CFP, image size 1534x1534 — 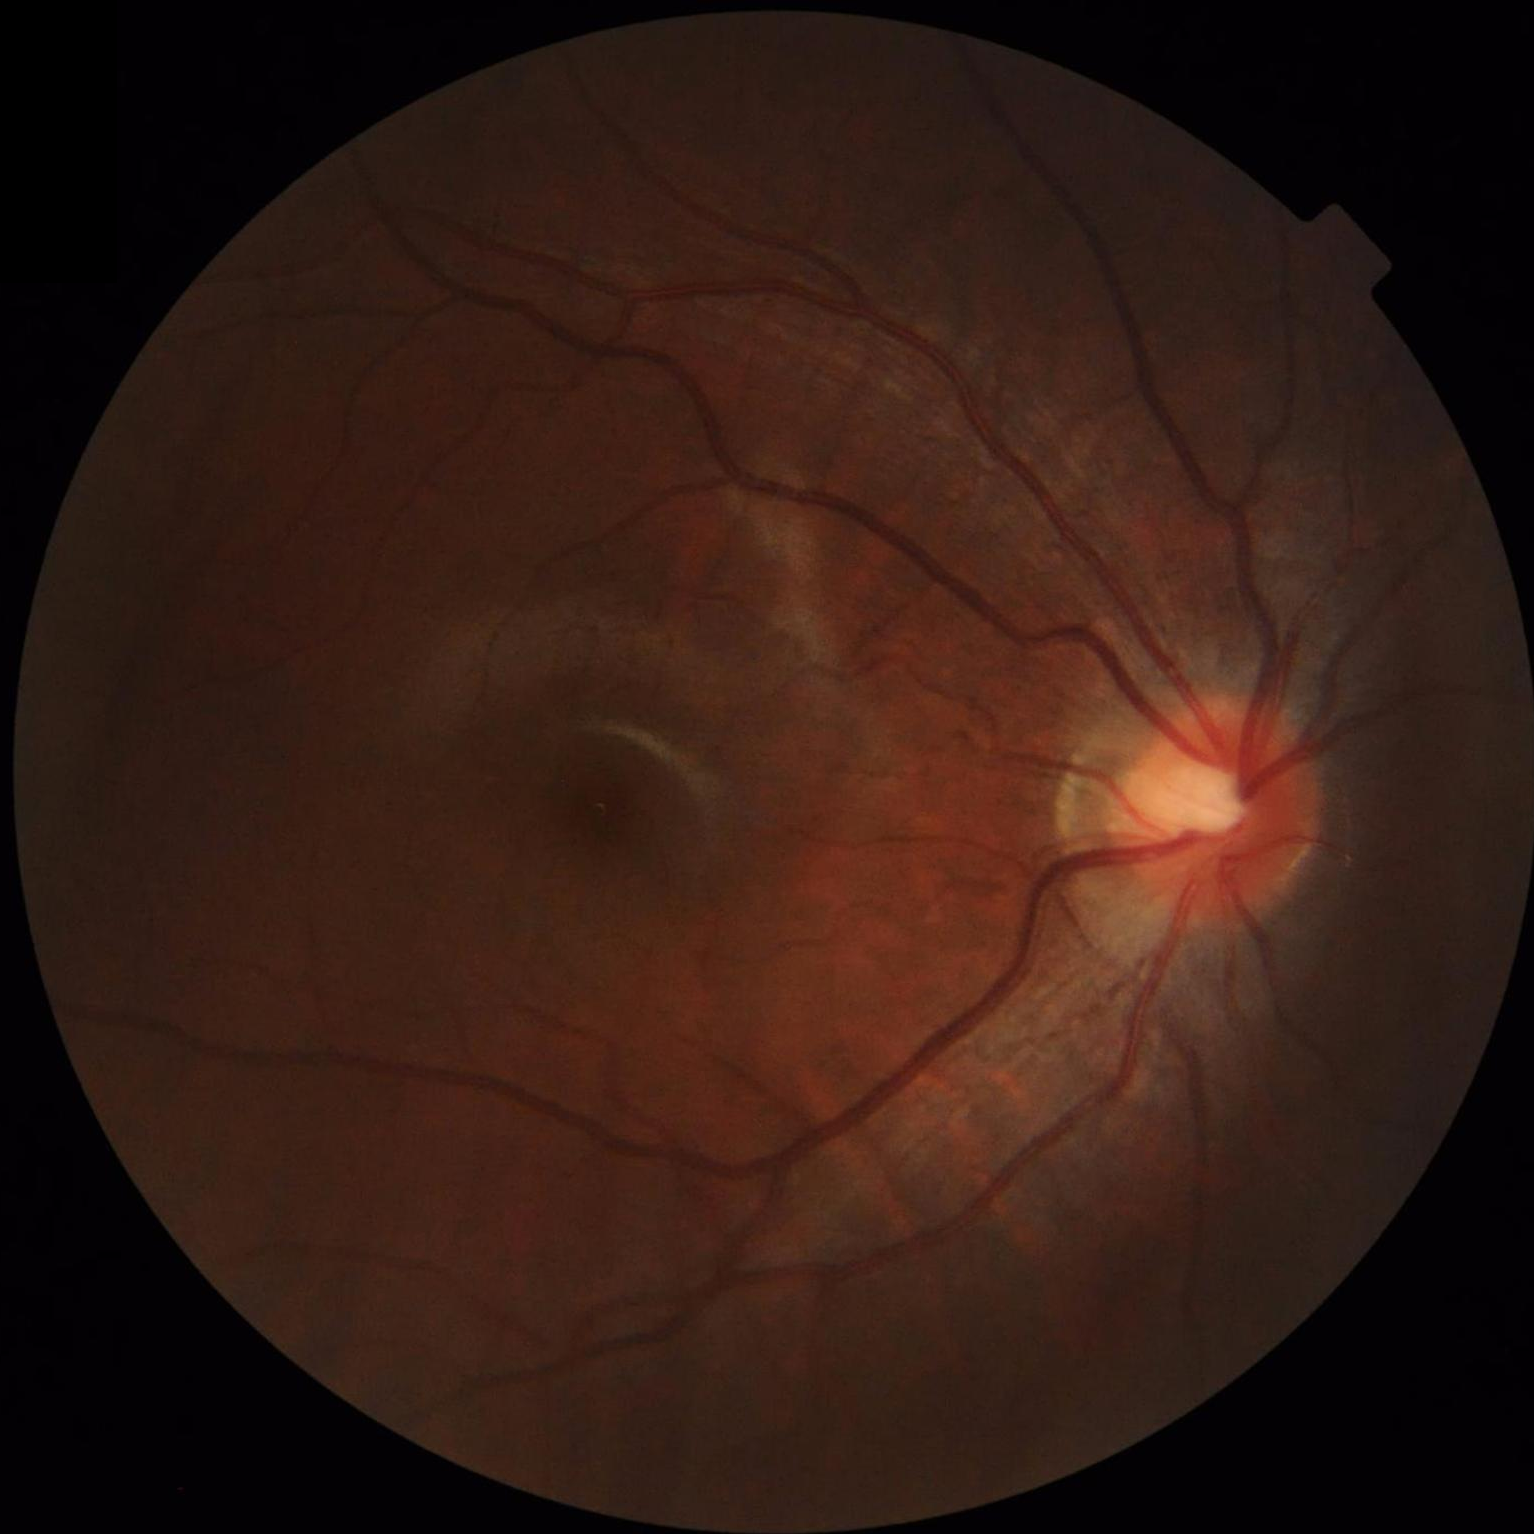 Sharpness: sharp throughout the field
Contrast: good dynamic range
Illumination: over- or under-exposed
Overall image quality: good and suitable for diagnostic use